Retinal fundus photograph. Non-mydriatic. Optic disc region crop: 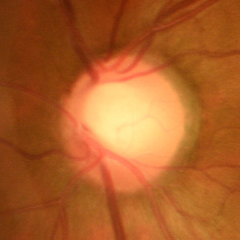

The image shows early glaucomatous changes.